45-degree field of view — 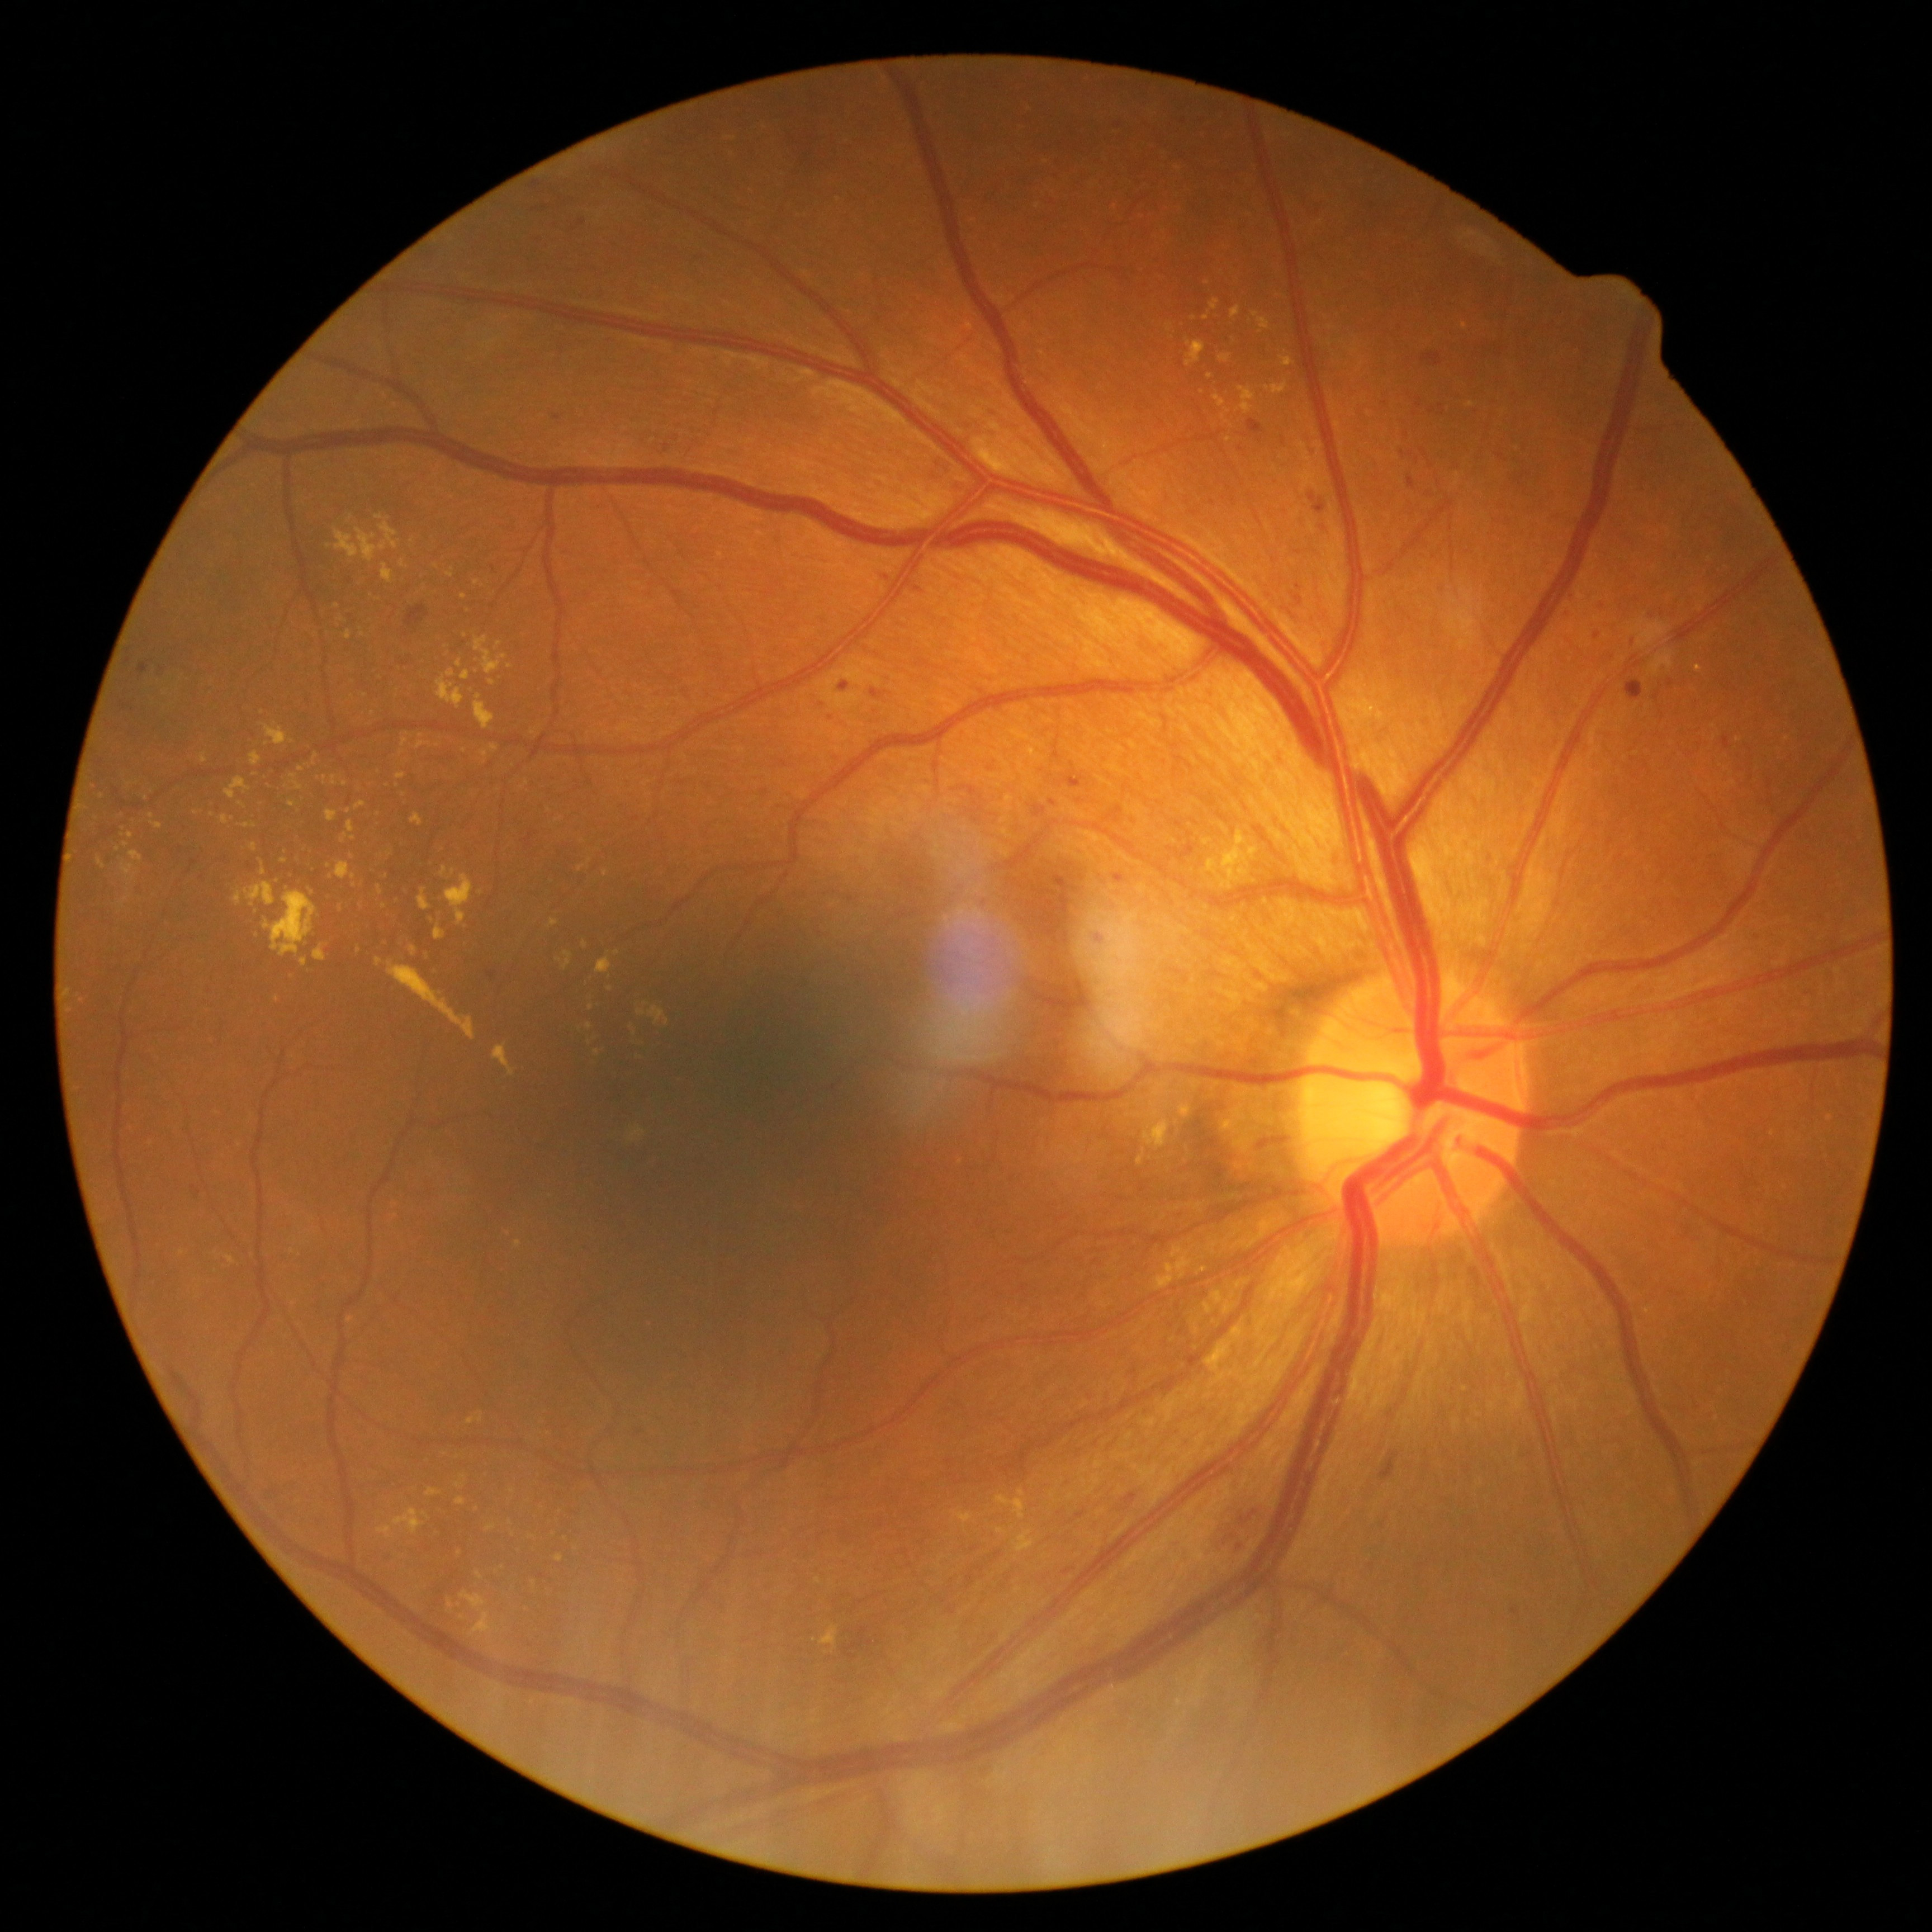

Diabetic retinopathy (DR): moderate NPDR (grade 2)
Representative lesions:
hard exudates (EXs) (partial) = bbox=(418, 742, 430, 750), bbox=(630, 1126, 646, 1142), bbox=(473, 695, 495, 730), bbox=(335, 863, 356, 880), bbox=(243, 822, 255, 828), bbox=(457, 1482, 465, 1488), bbox=(461, 1592, 500, 1635), bbox=(382, 564, 392, 583), bbox=(261, 868, 267, 877), bbox=(619, 724, 633, 733), bbox=(202, 753, 207, 763), bbox=(489, 744, 498, 753), bbox=(378, 887, 383, 895)
Additional small EXs near Point(611, 989), Point(1194, 318), Point(365, 695), Point(591, 1007), Point(103, 796), Point(533, 733)